Acquired with a NIDEK AFC-230; Davis DR grading; 45-degree field of view.
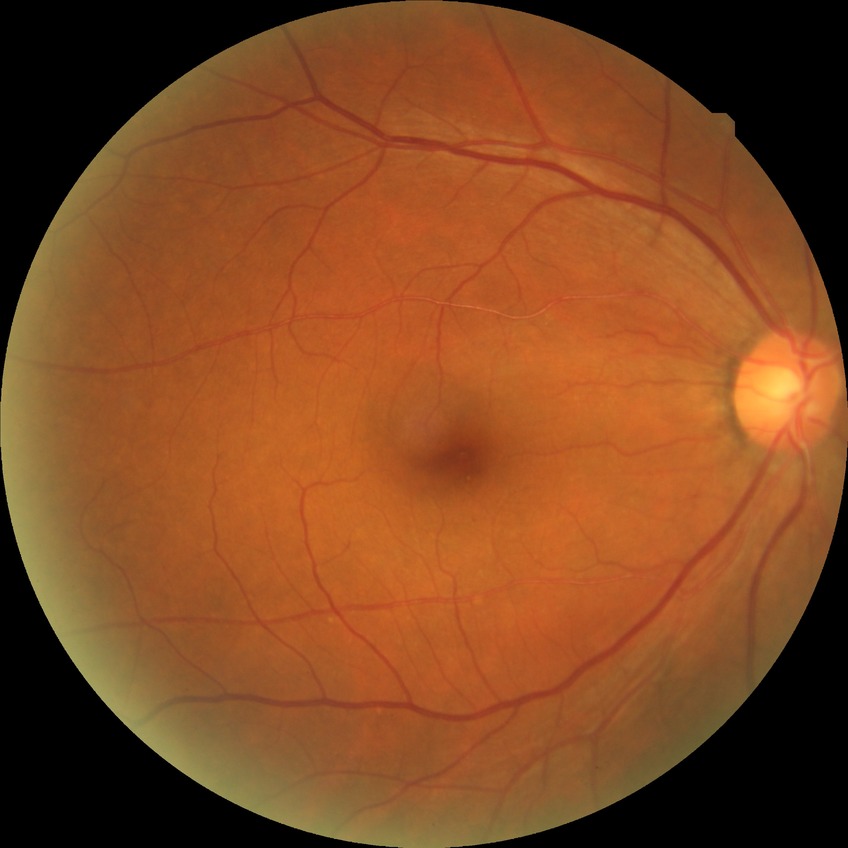 Diabetic retinopathy (DR) is no diabetic retinopathy (NDR).